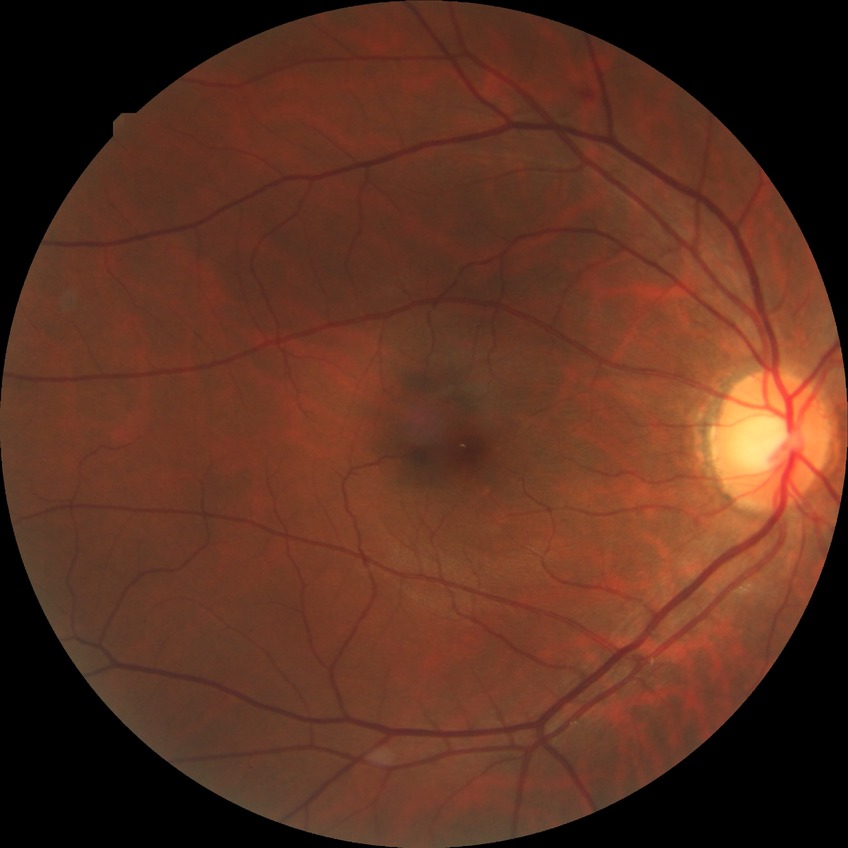
Diabetic retinopathy severity is simple diabetic retinopathy. The retinopathy is classified as non-proliferative diabetic retinopathy.